RetCam wide-field infant fundus image
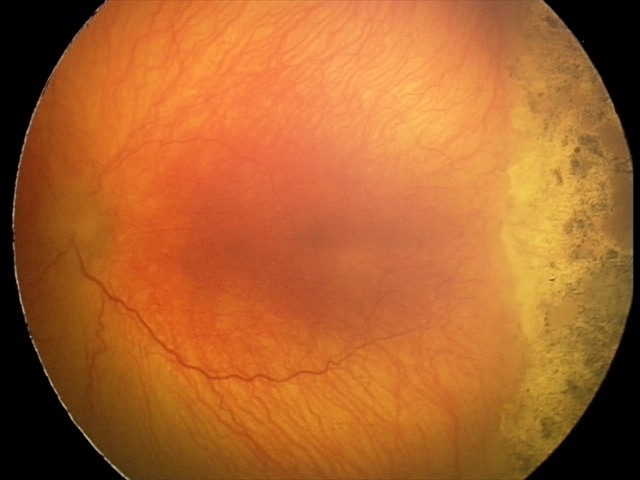 Plus disease present.
Examination diagnosed as aggressive ROP (A-ROP).